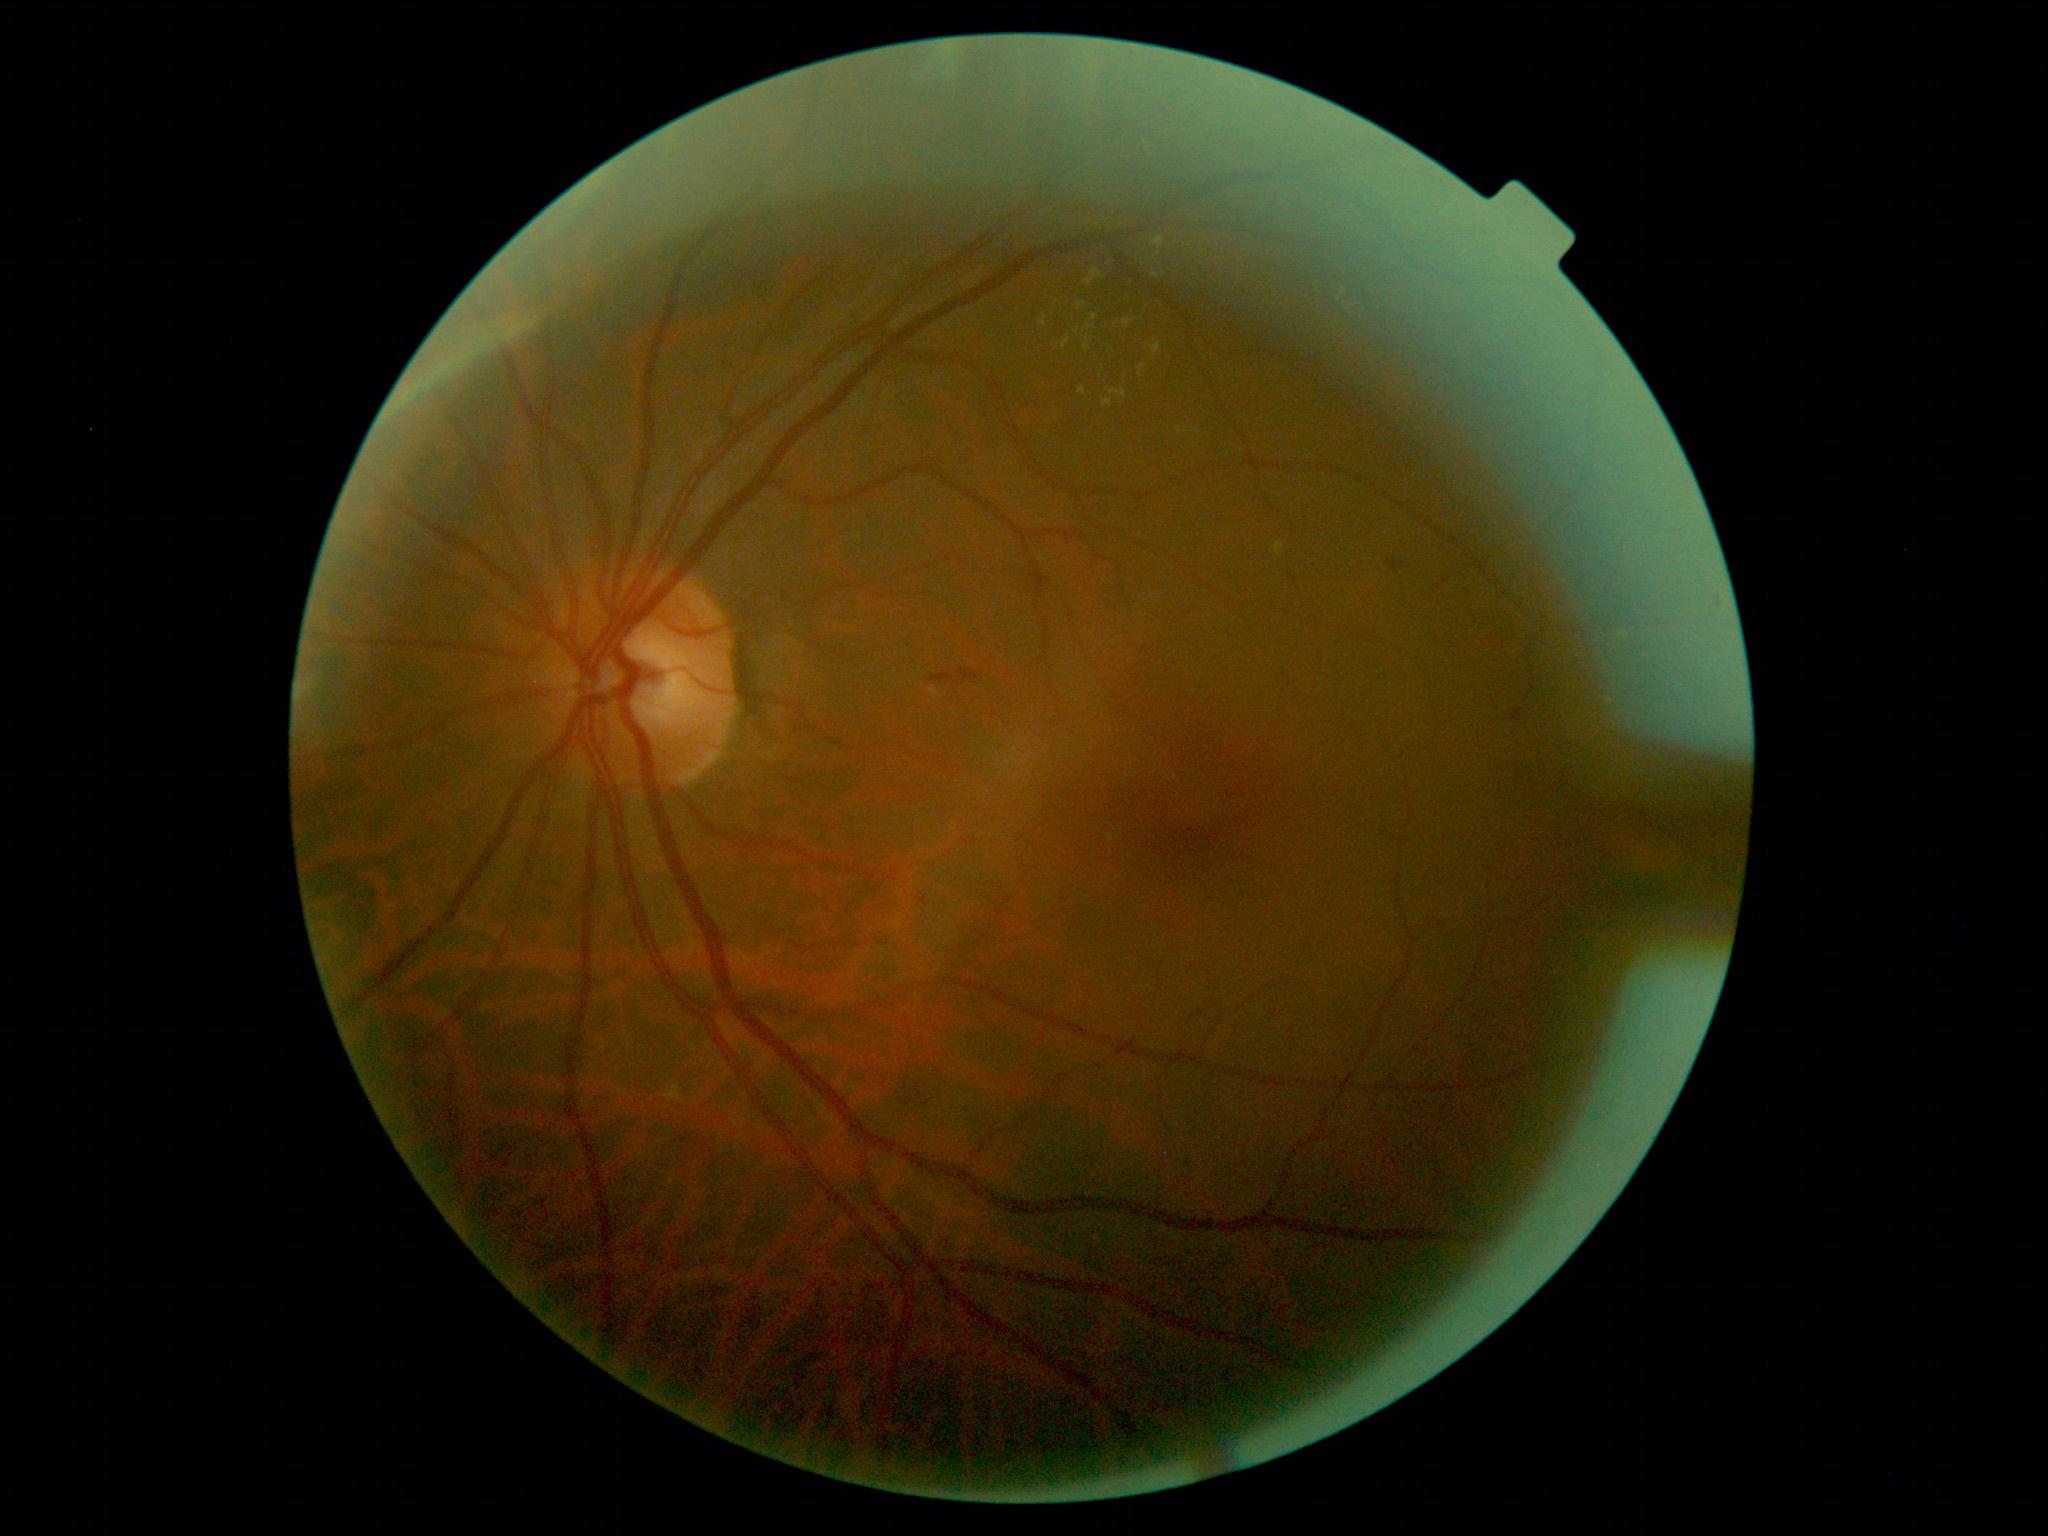
diabetic retinopathy severity: grade 2 (moderate NPDR).